Wide-field fundus photograph from neonatal ROP screening; 130° field of view (Clarity RetCam 3)
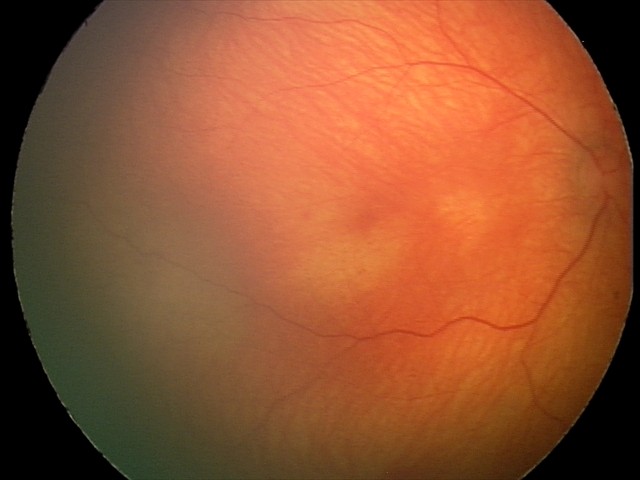

No retinal pathology identified on screening.